Mydriatic (tropicamide phenylephrine 1.0%).
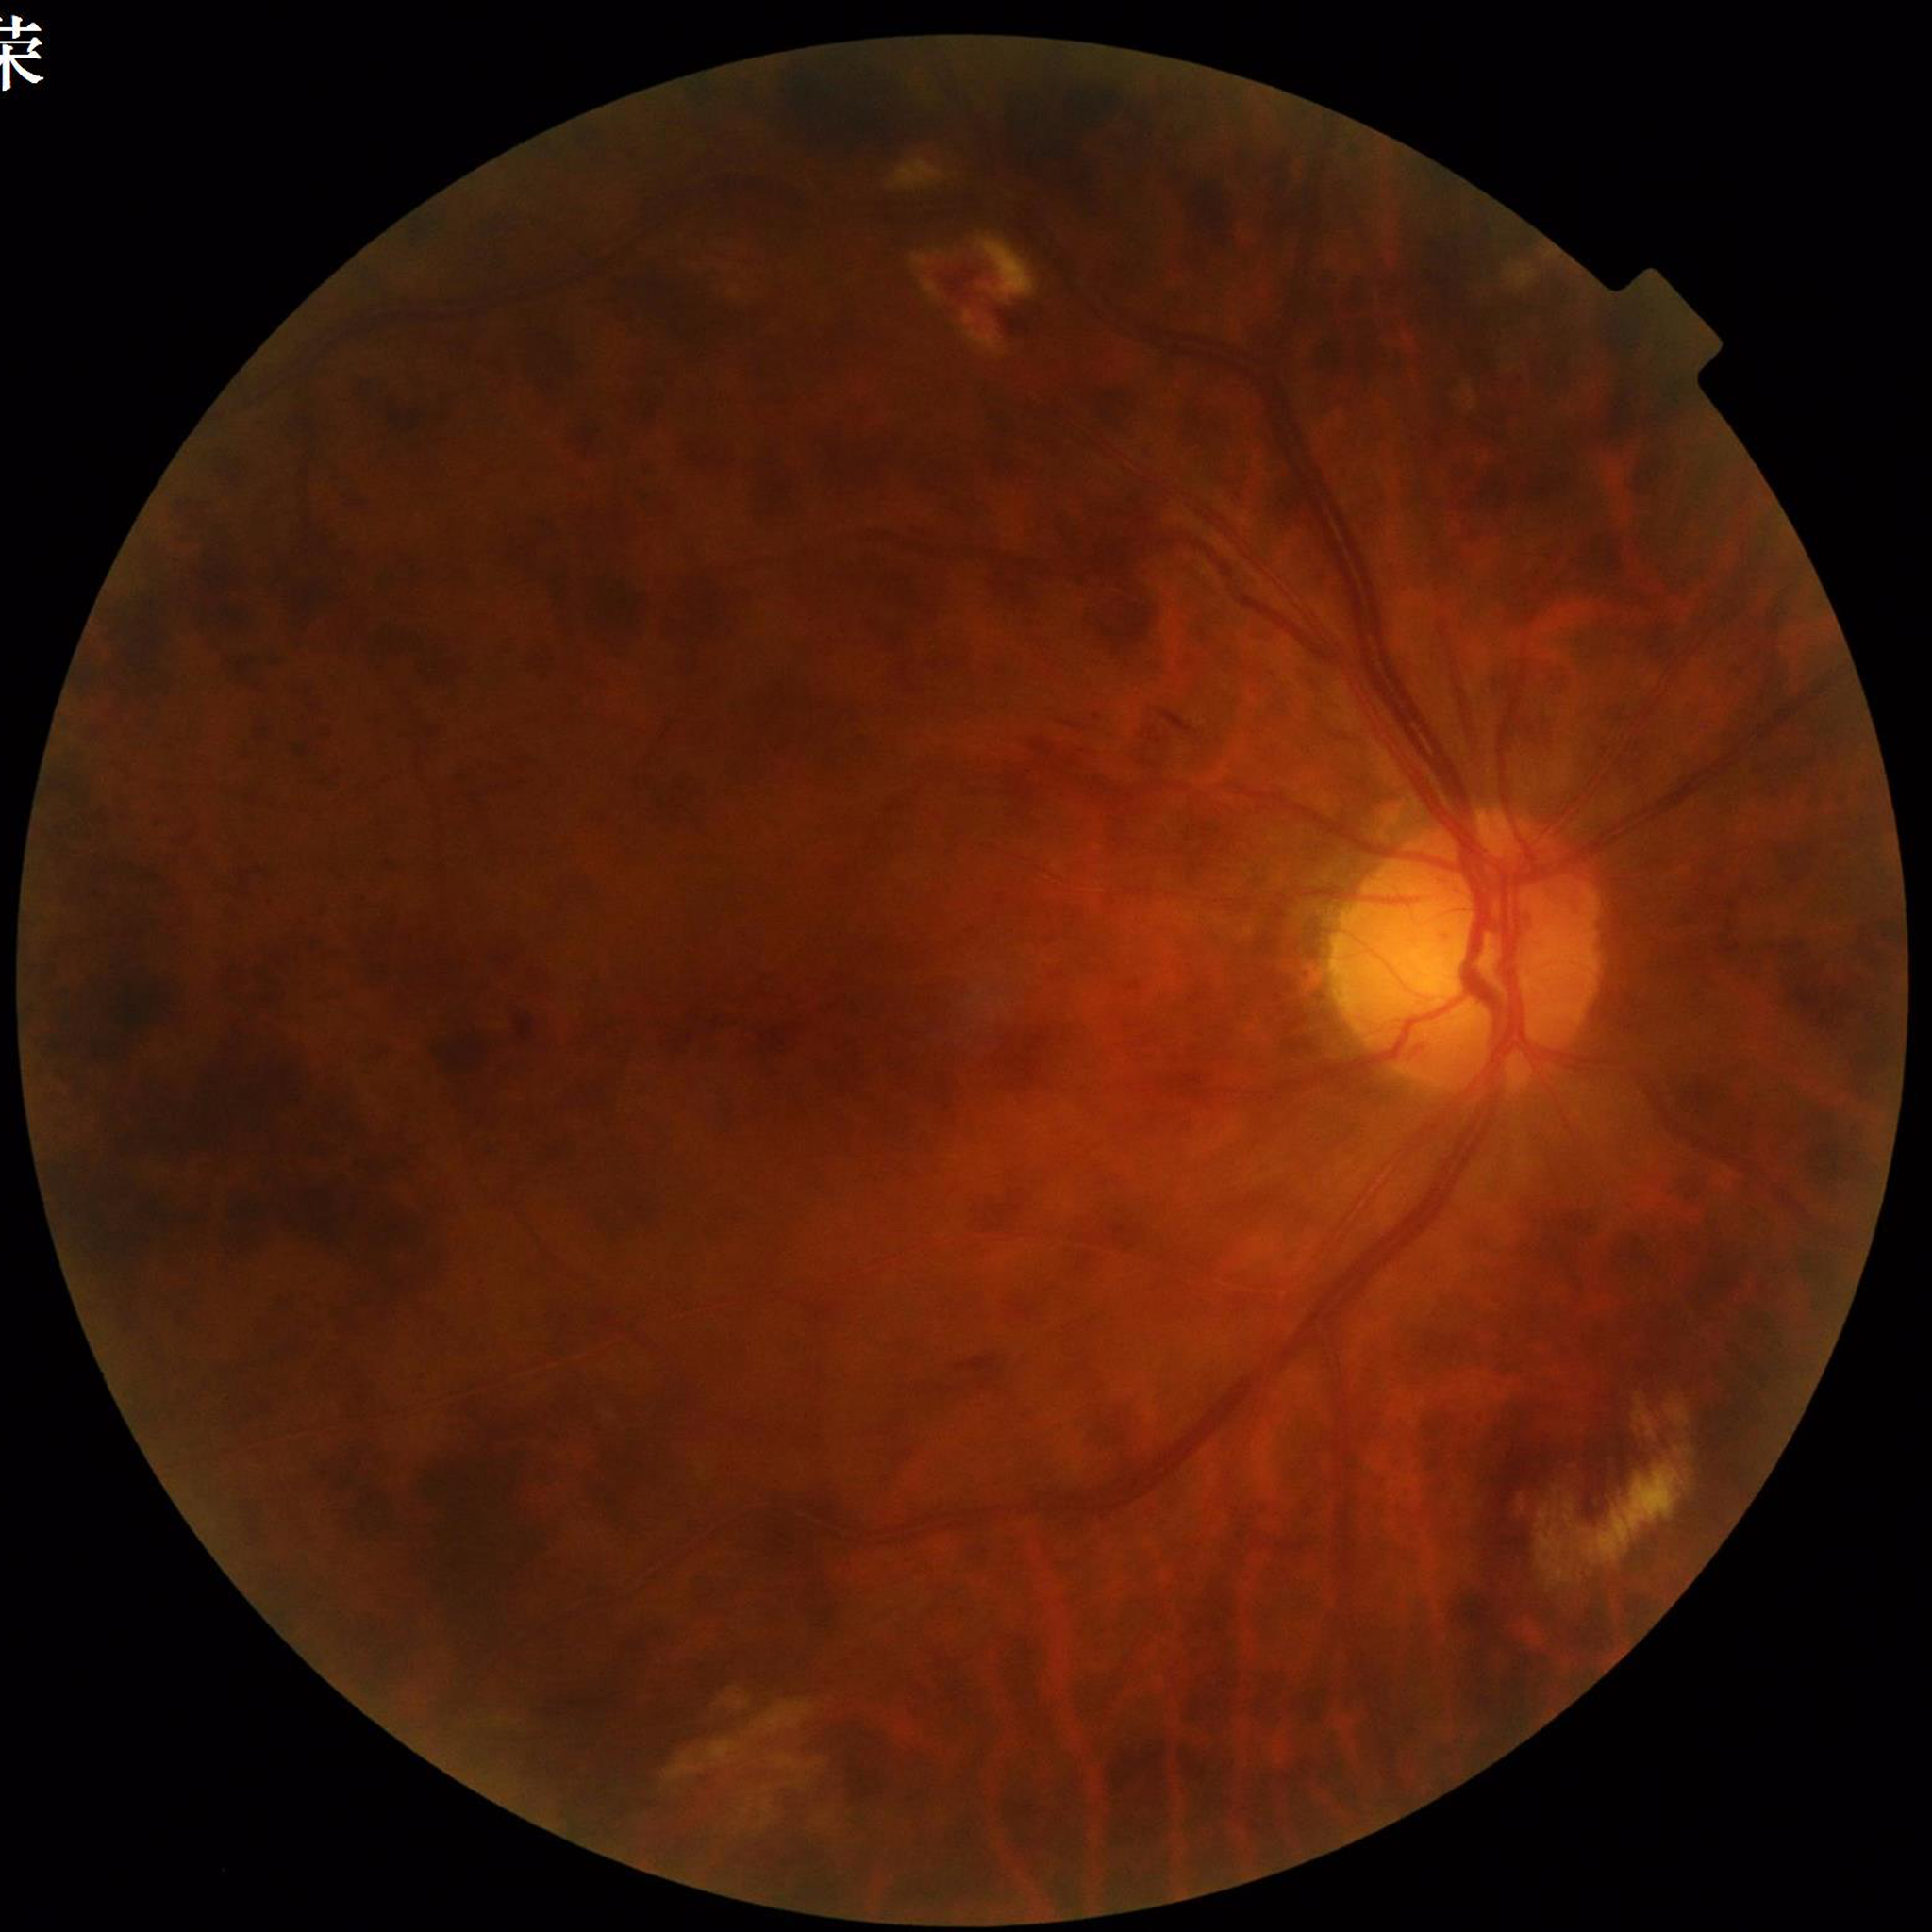
Retinal fundus photograph from a patient with diabetic retinopathy. Image quality: reduced — blur.